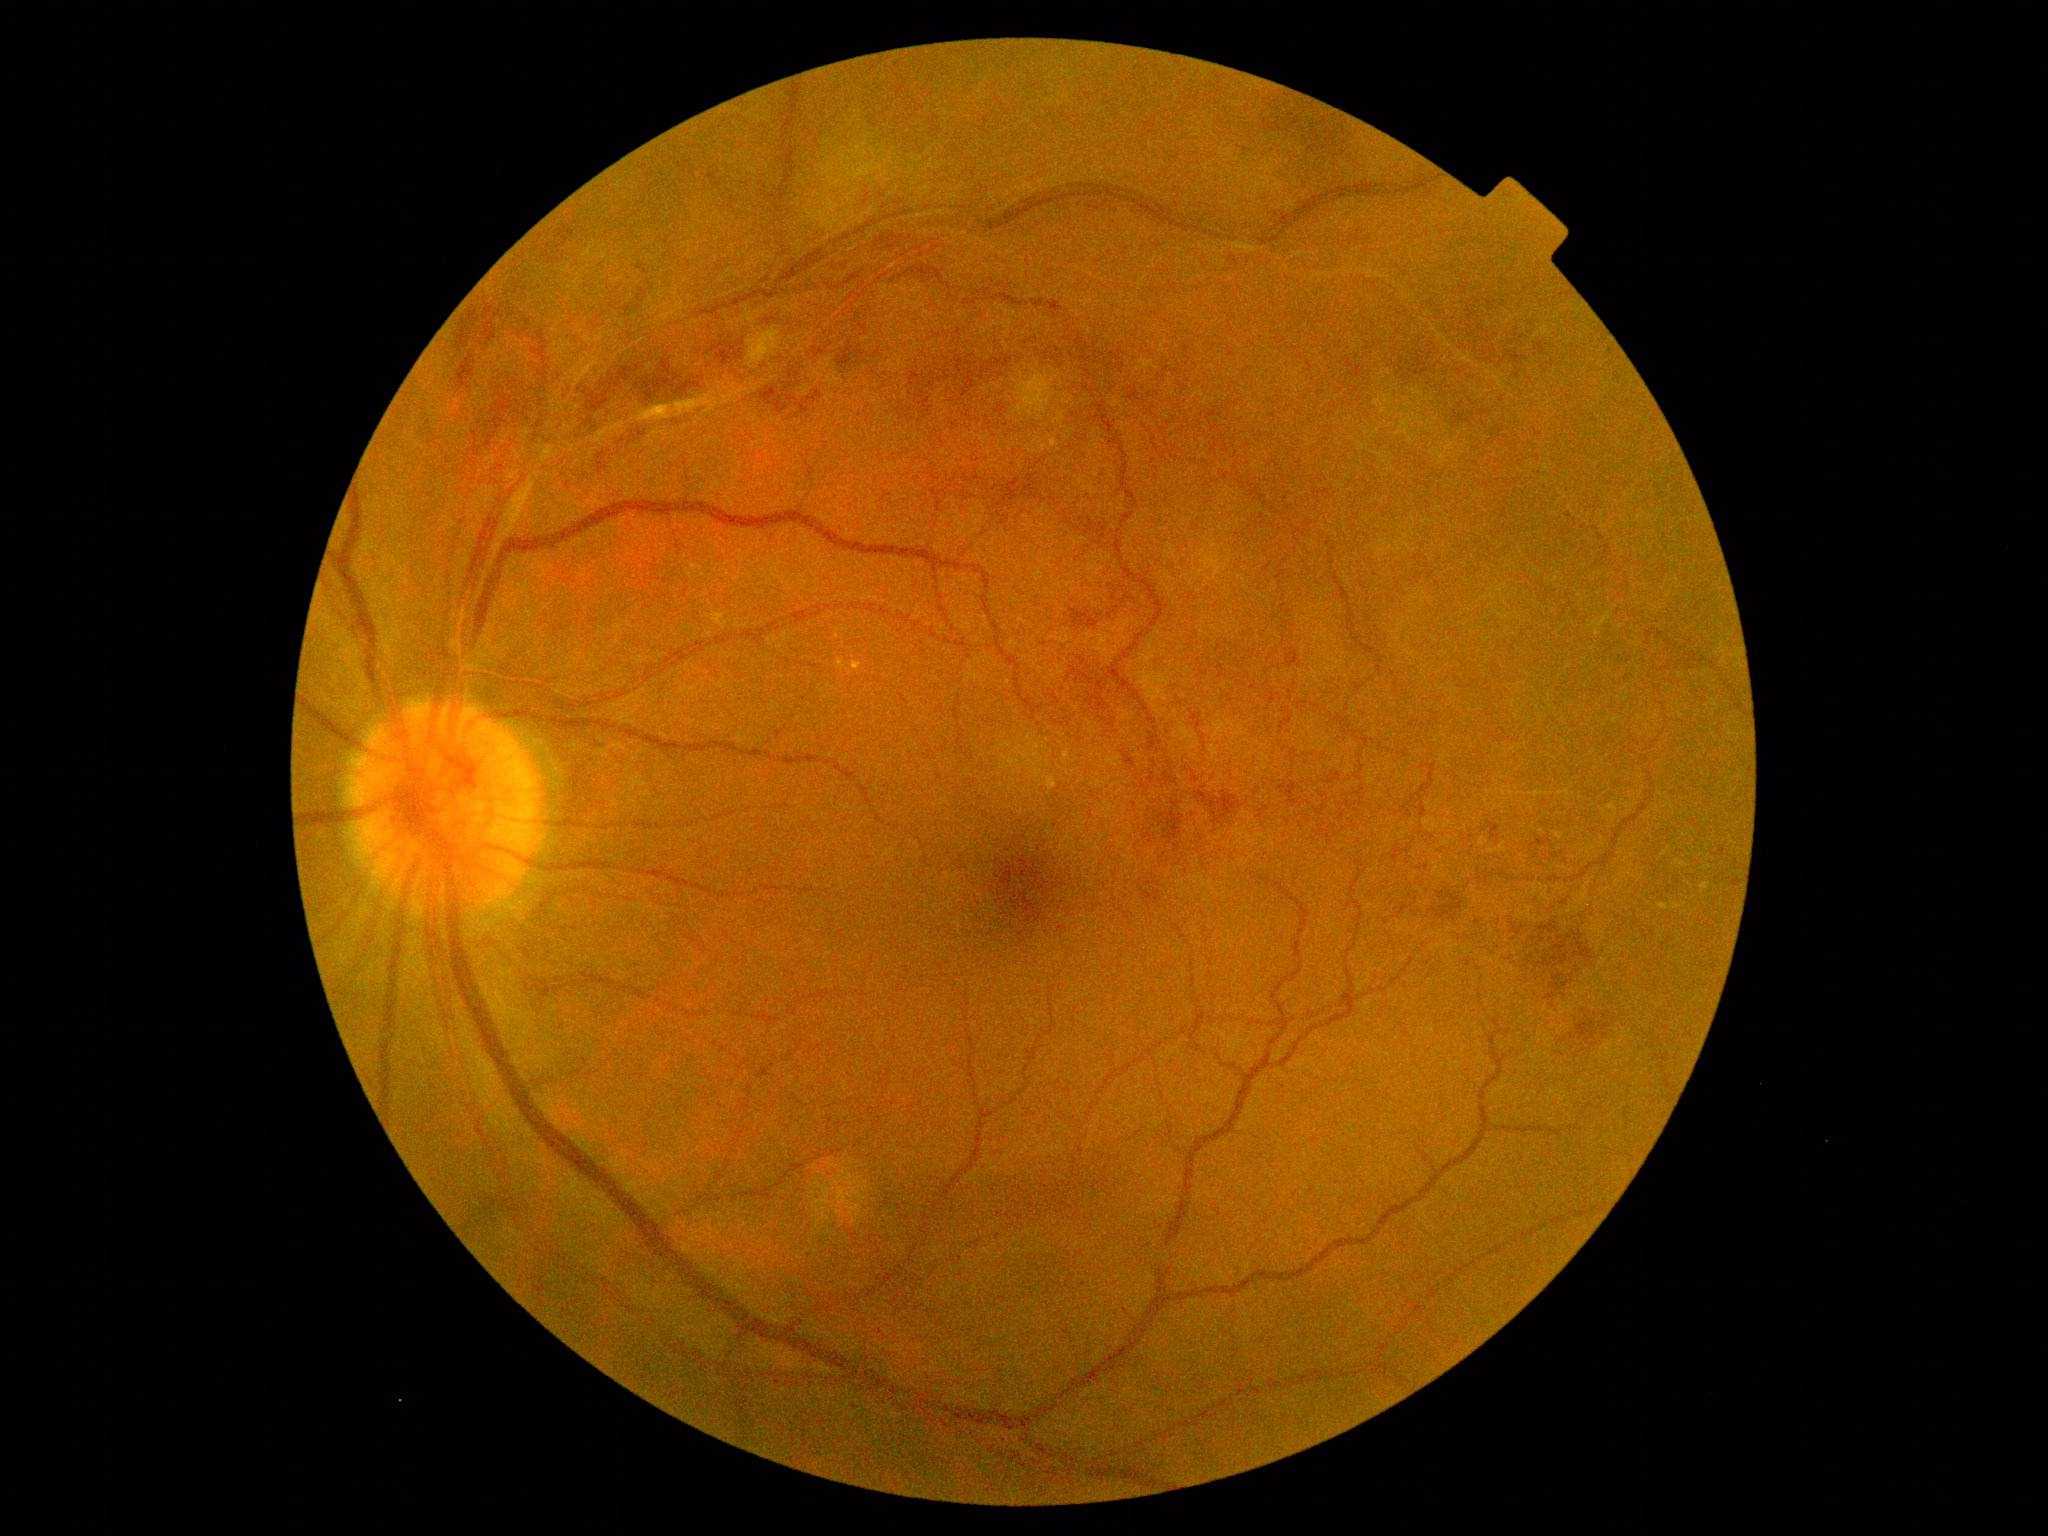
Retinopathy: 2.